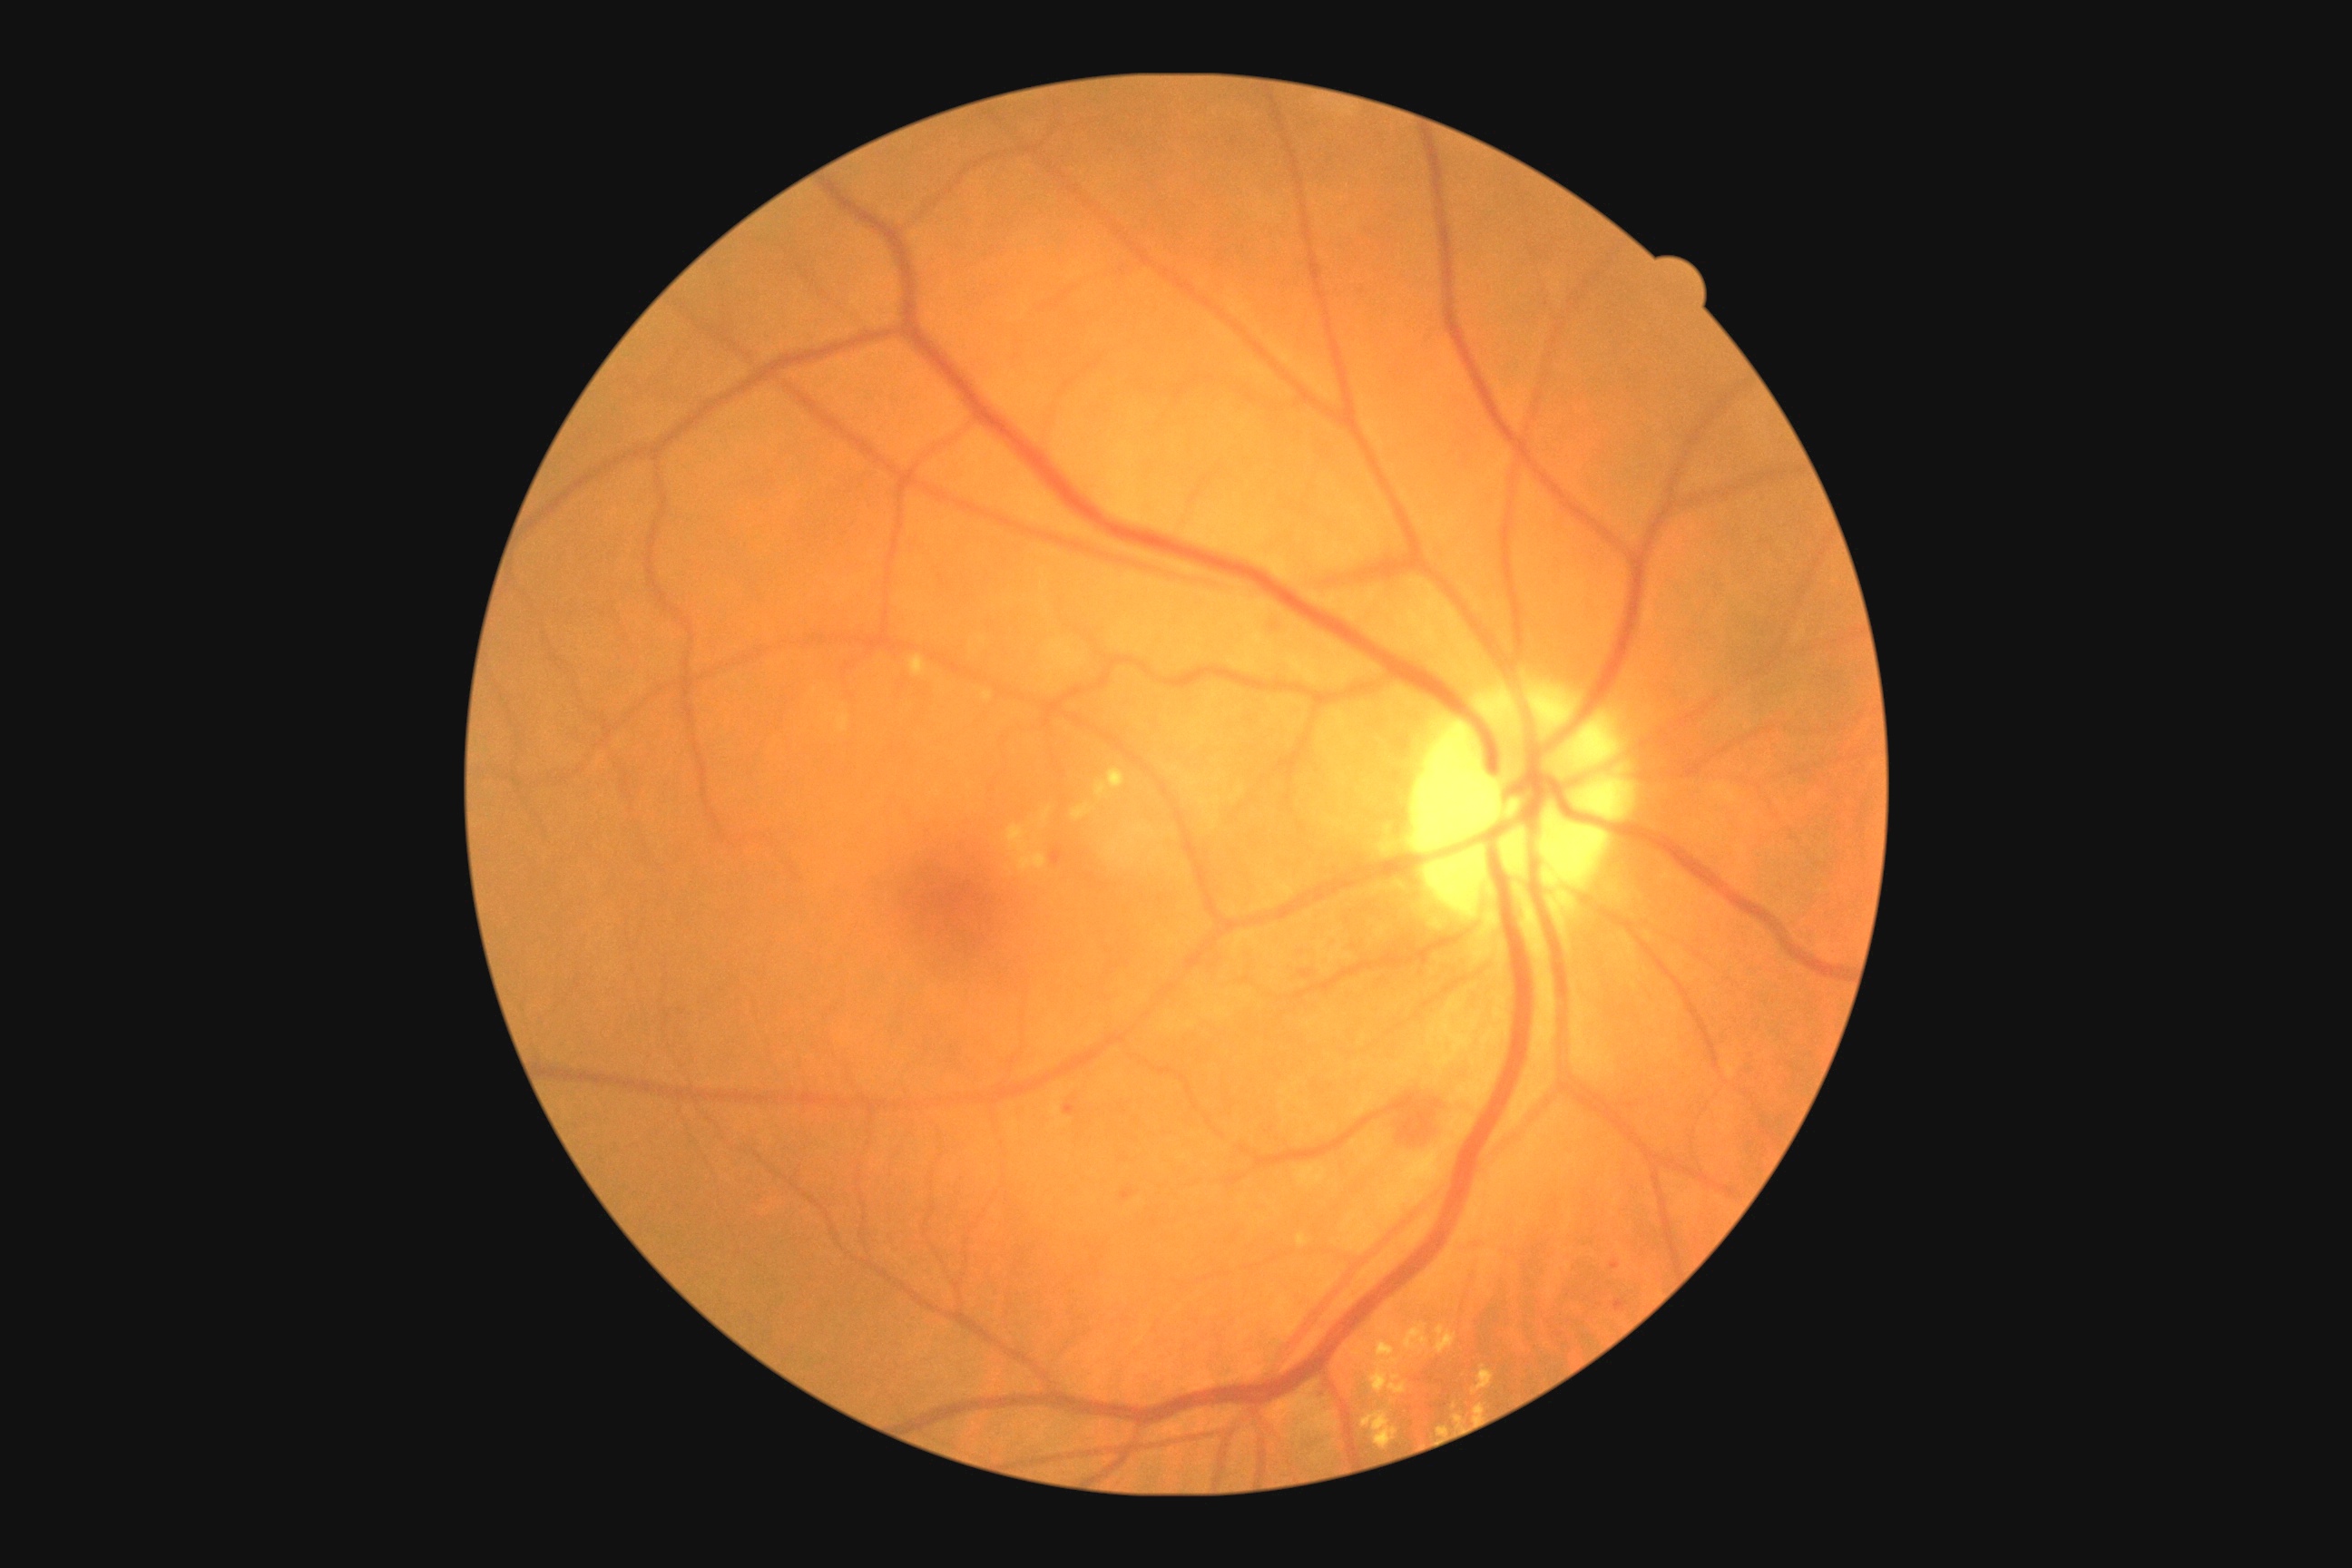
Diabetic retinopathy (DR): 2/4.